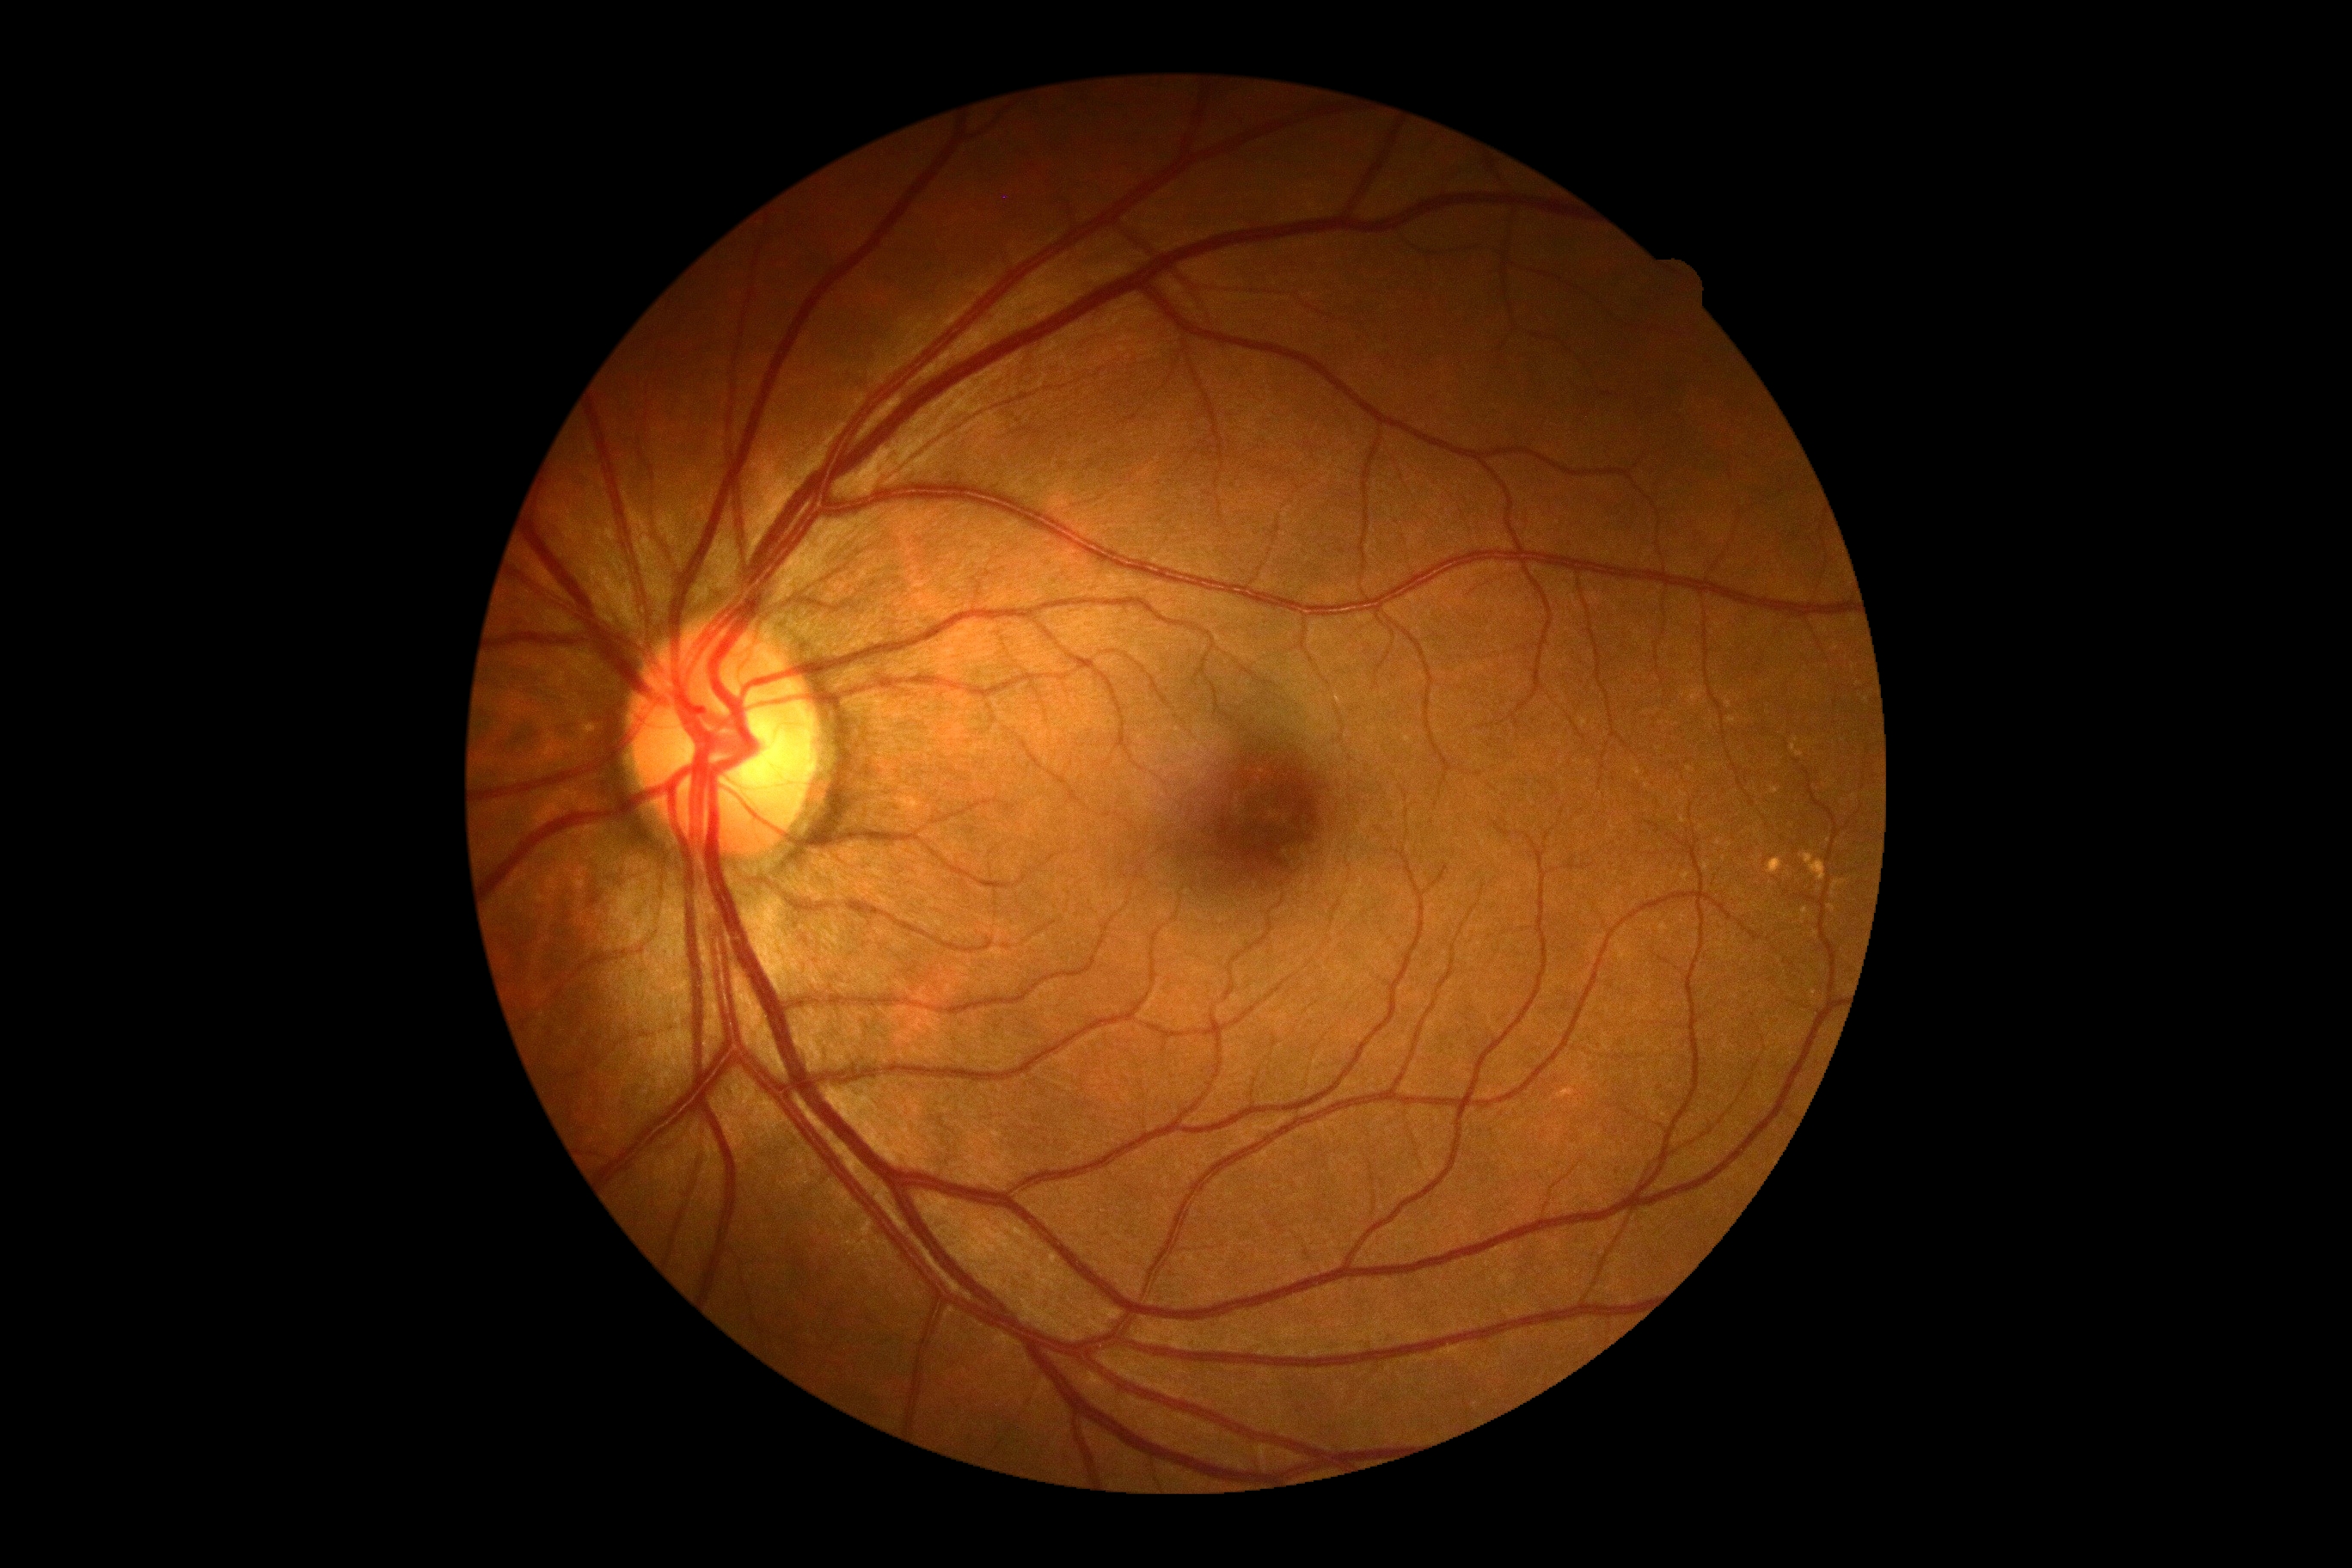 Retinopathy grade: 0 (no apparent retinopathy).